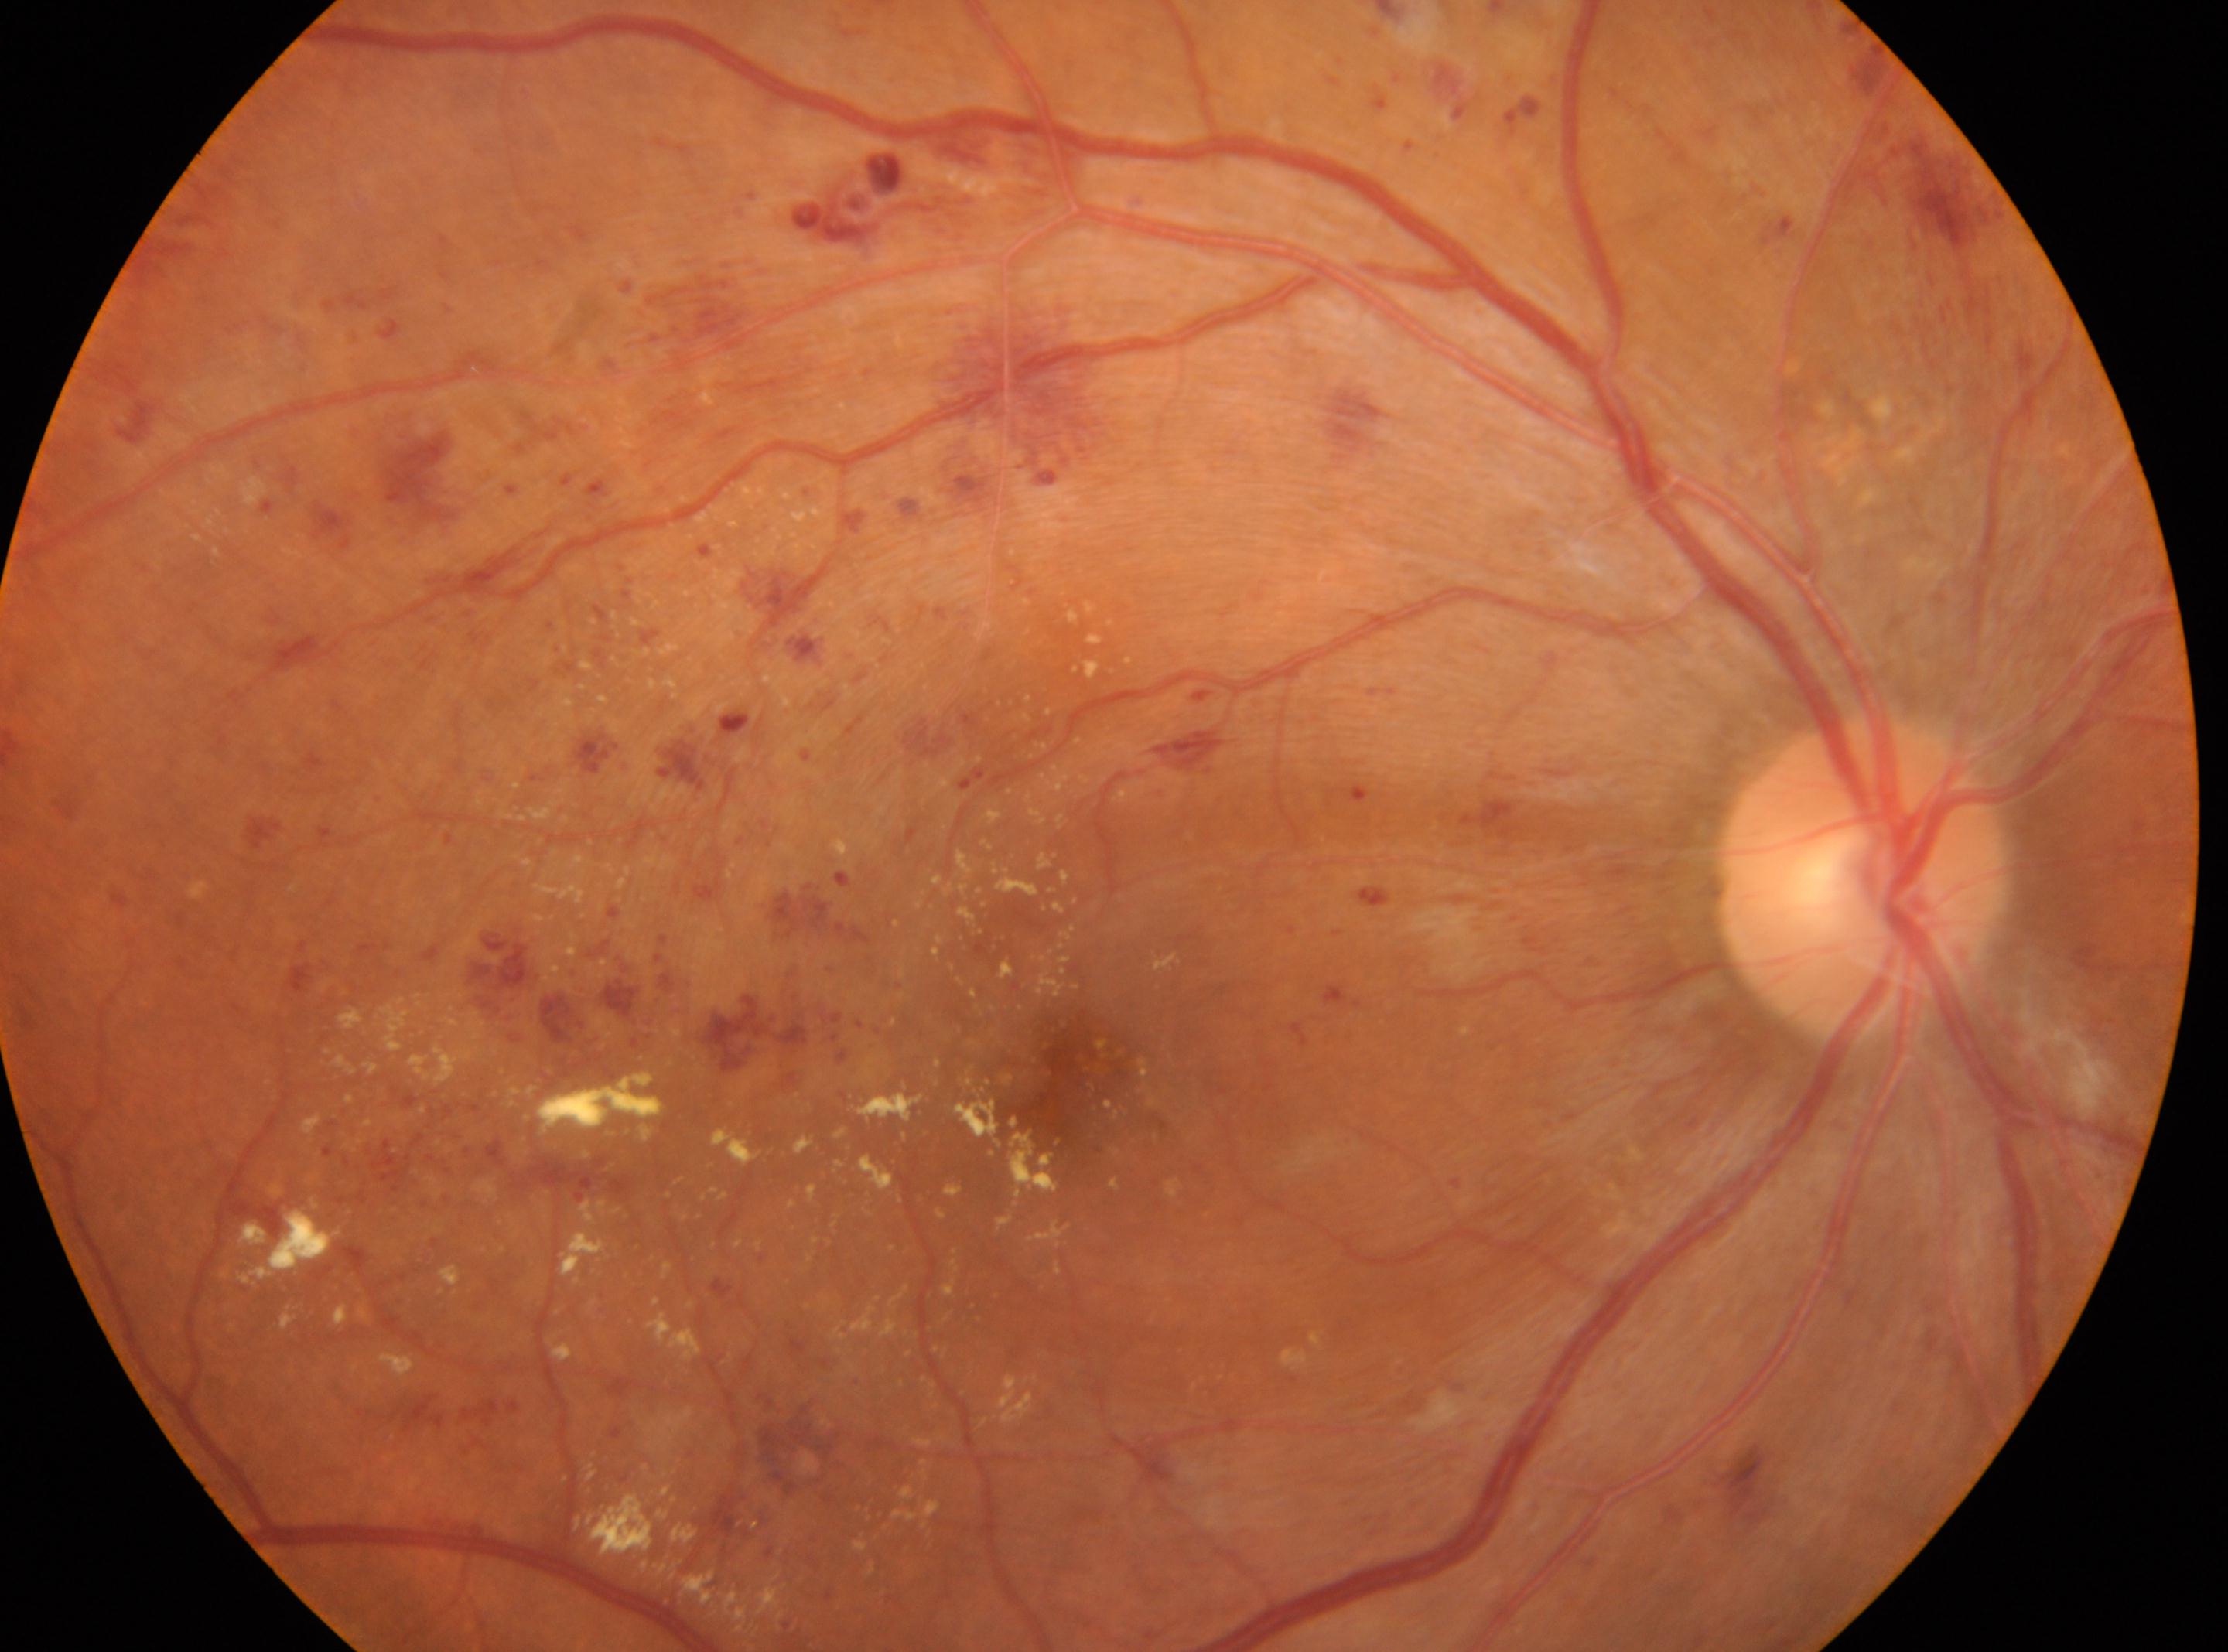

{
  "fovea": "x=1082, y=1073",
  "eye": "oculus dexter",
  "dr_grade": "3",
  "optic_disc": "x=1861, y=877"
}